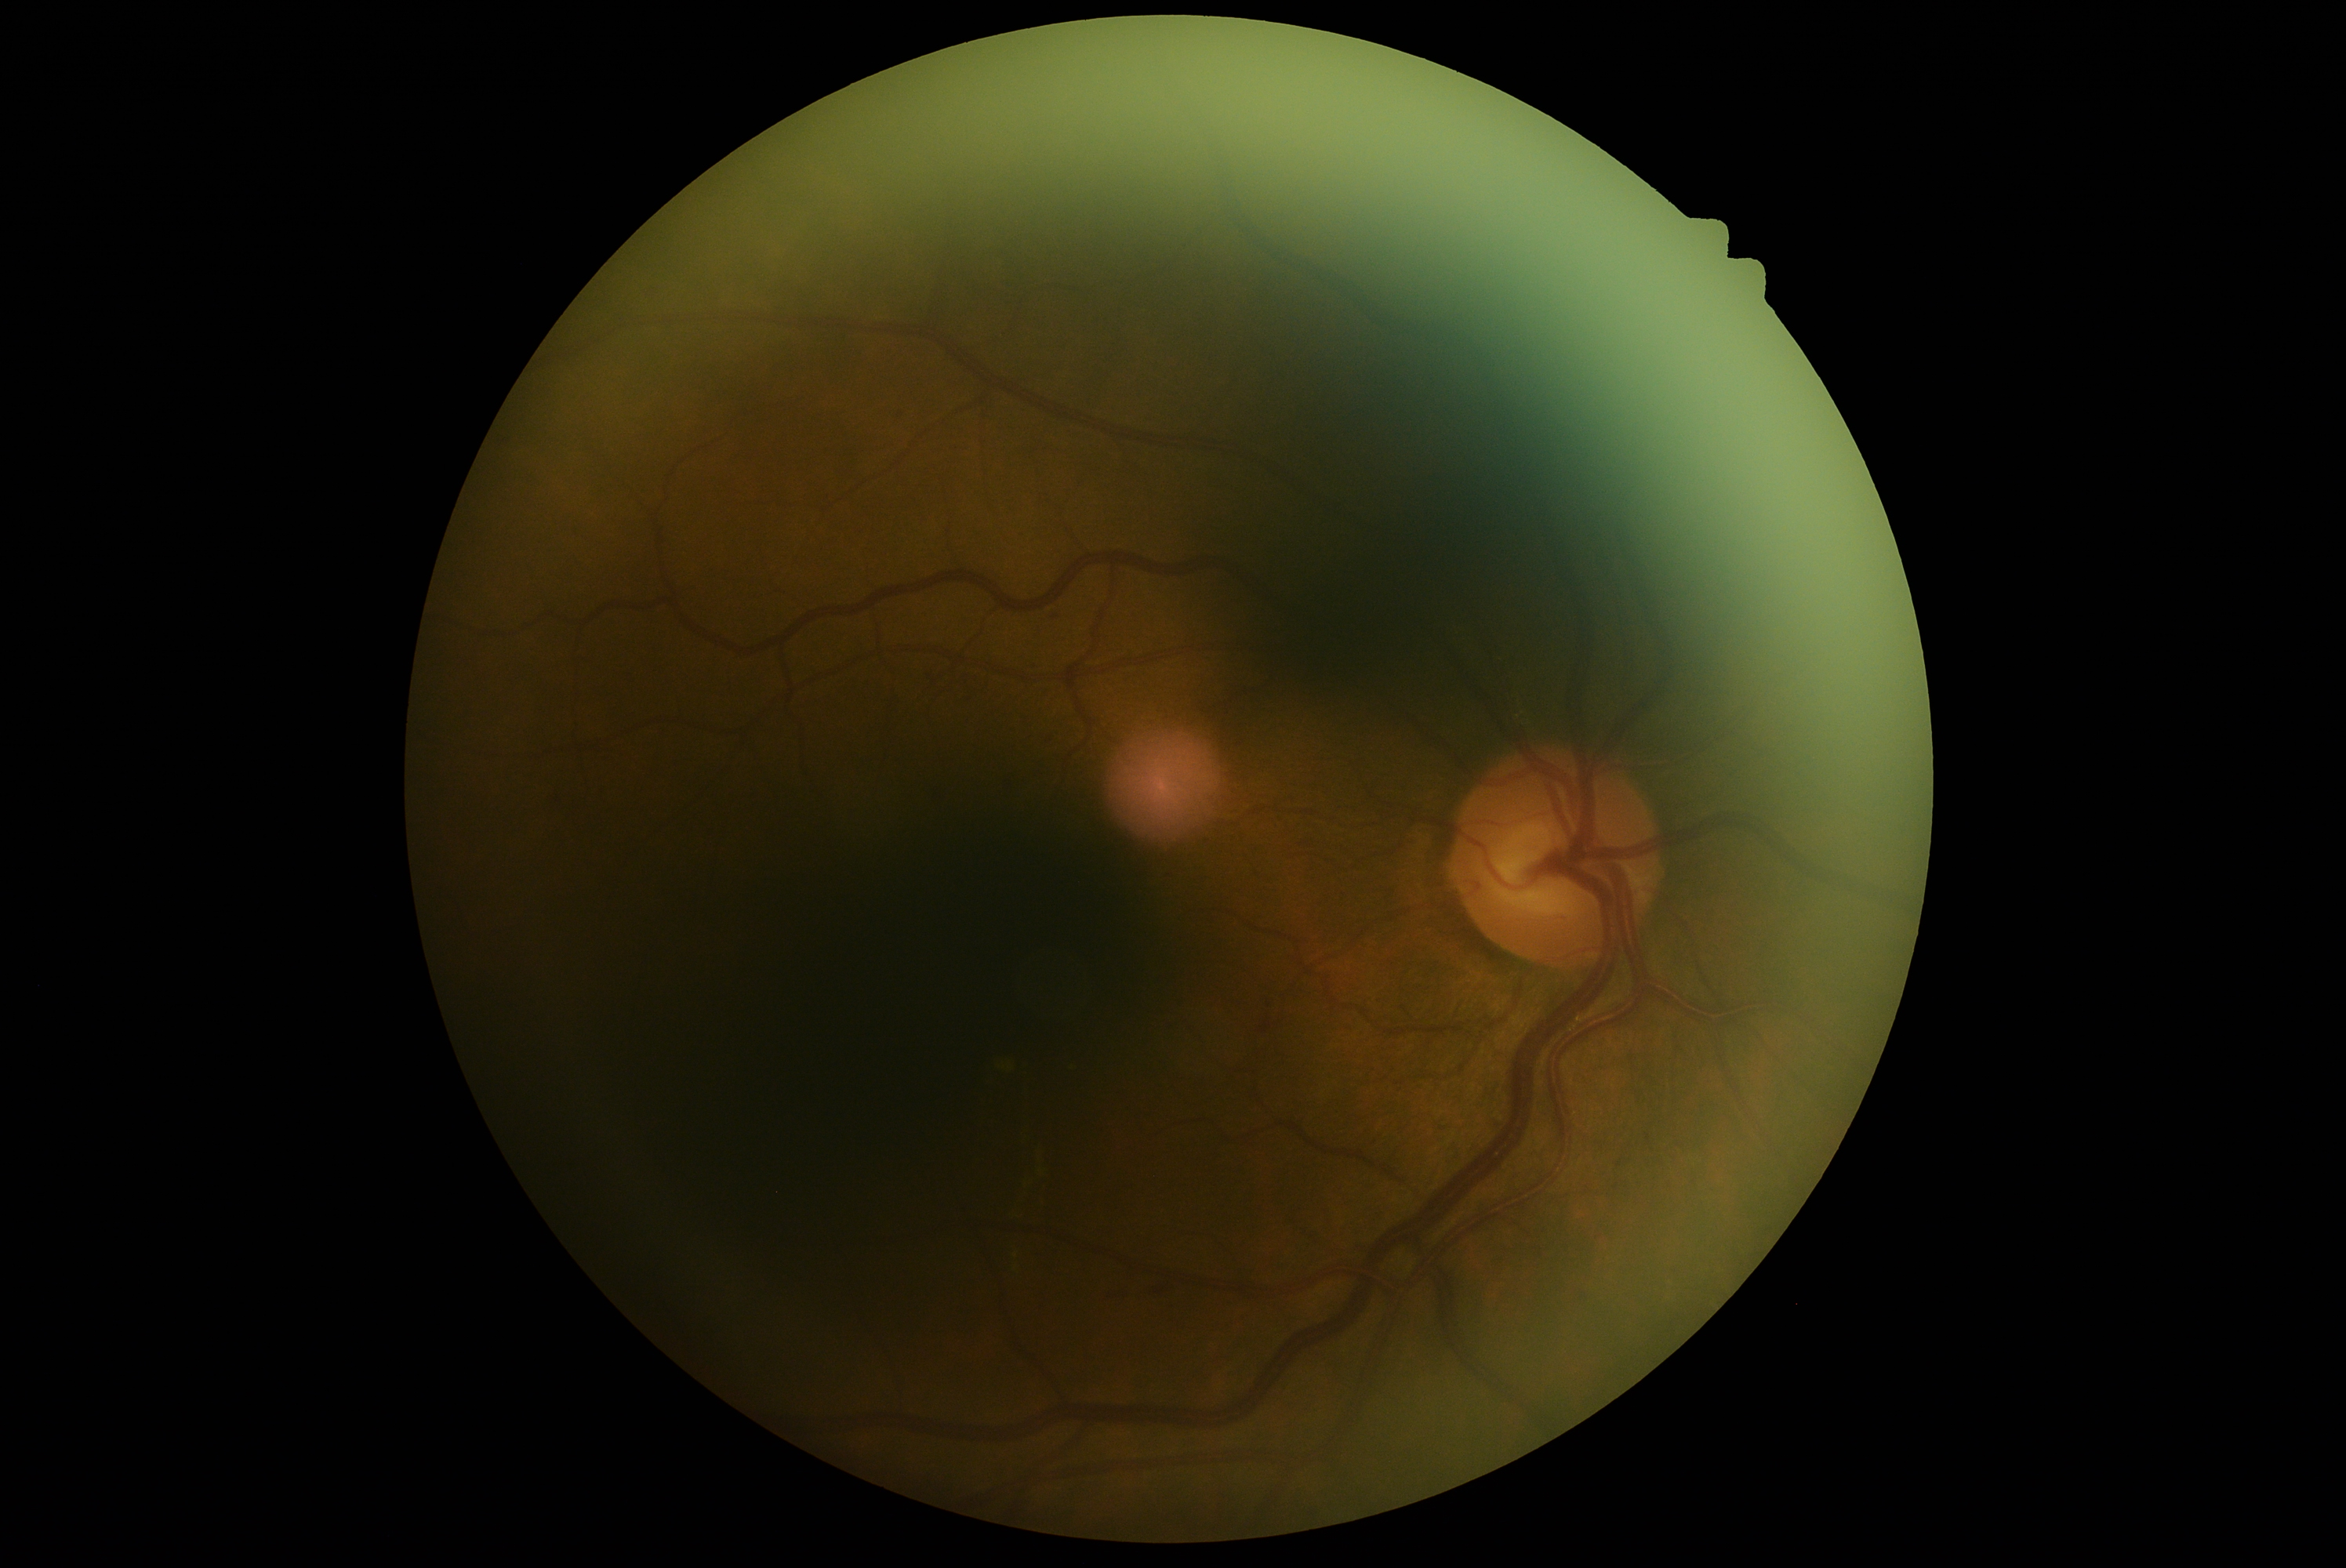

DR: moderate NPDR (grade 2).